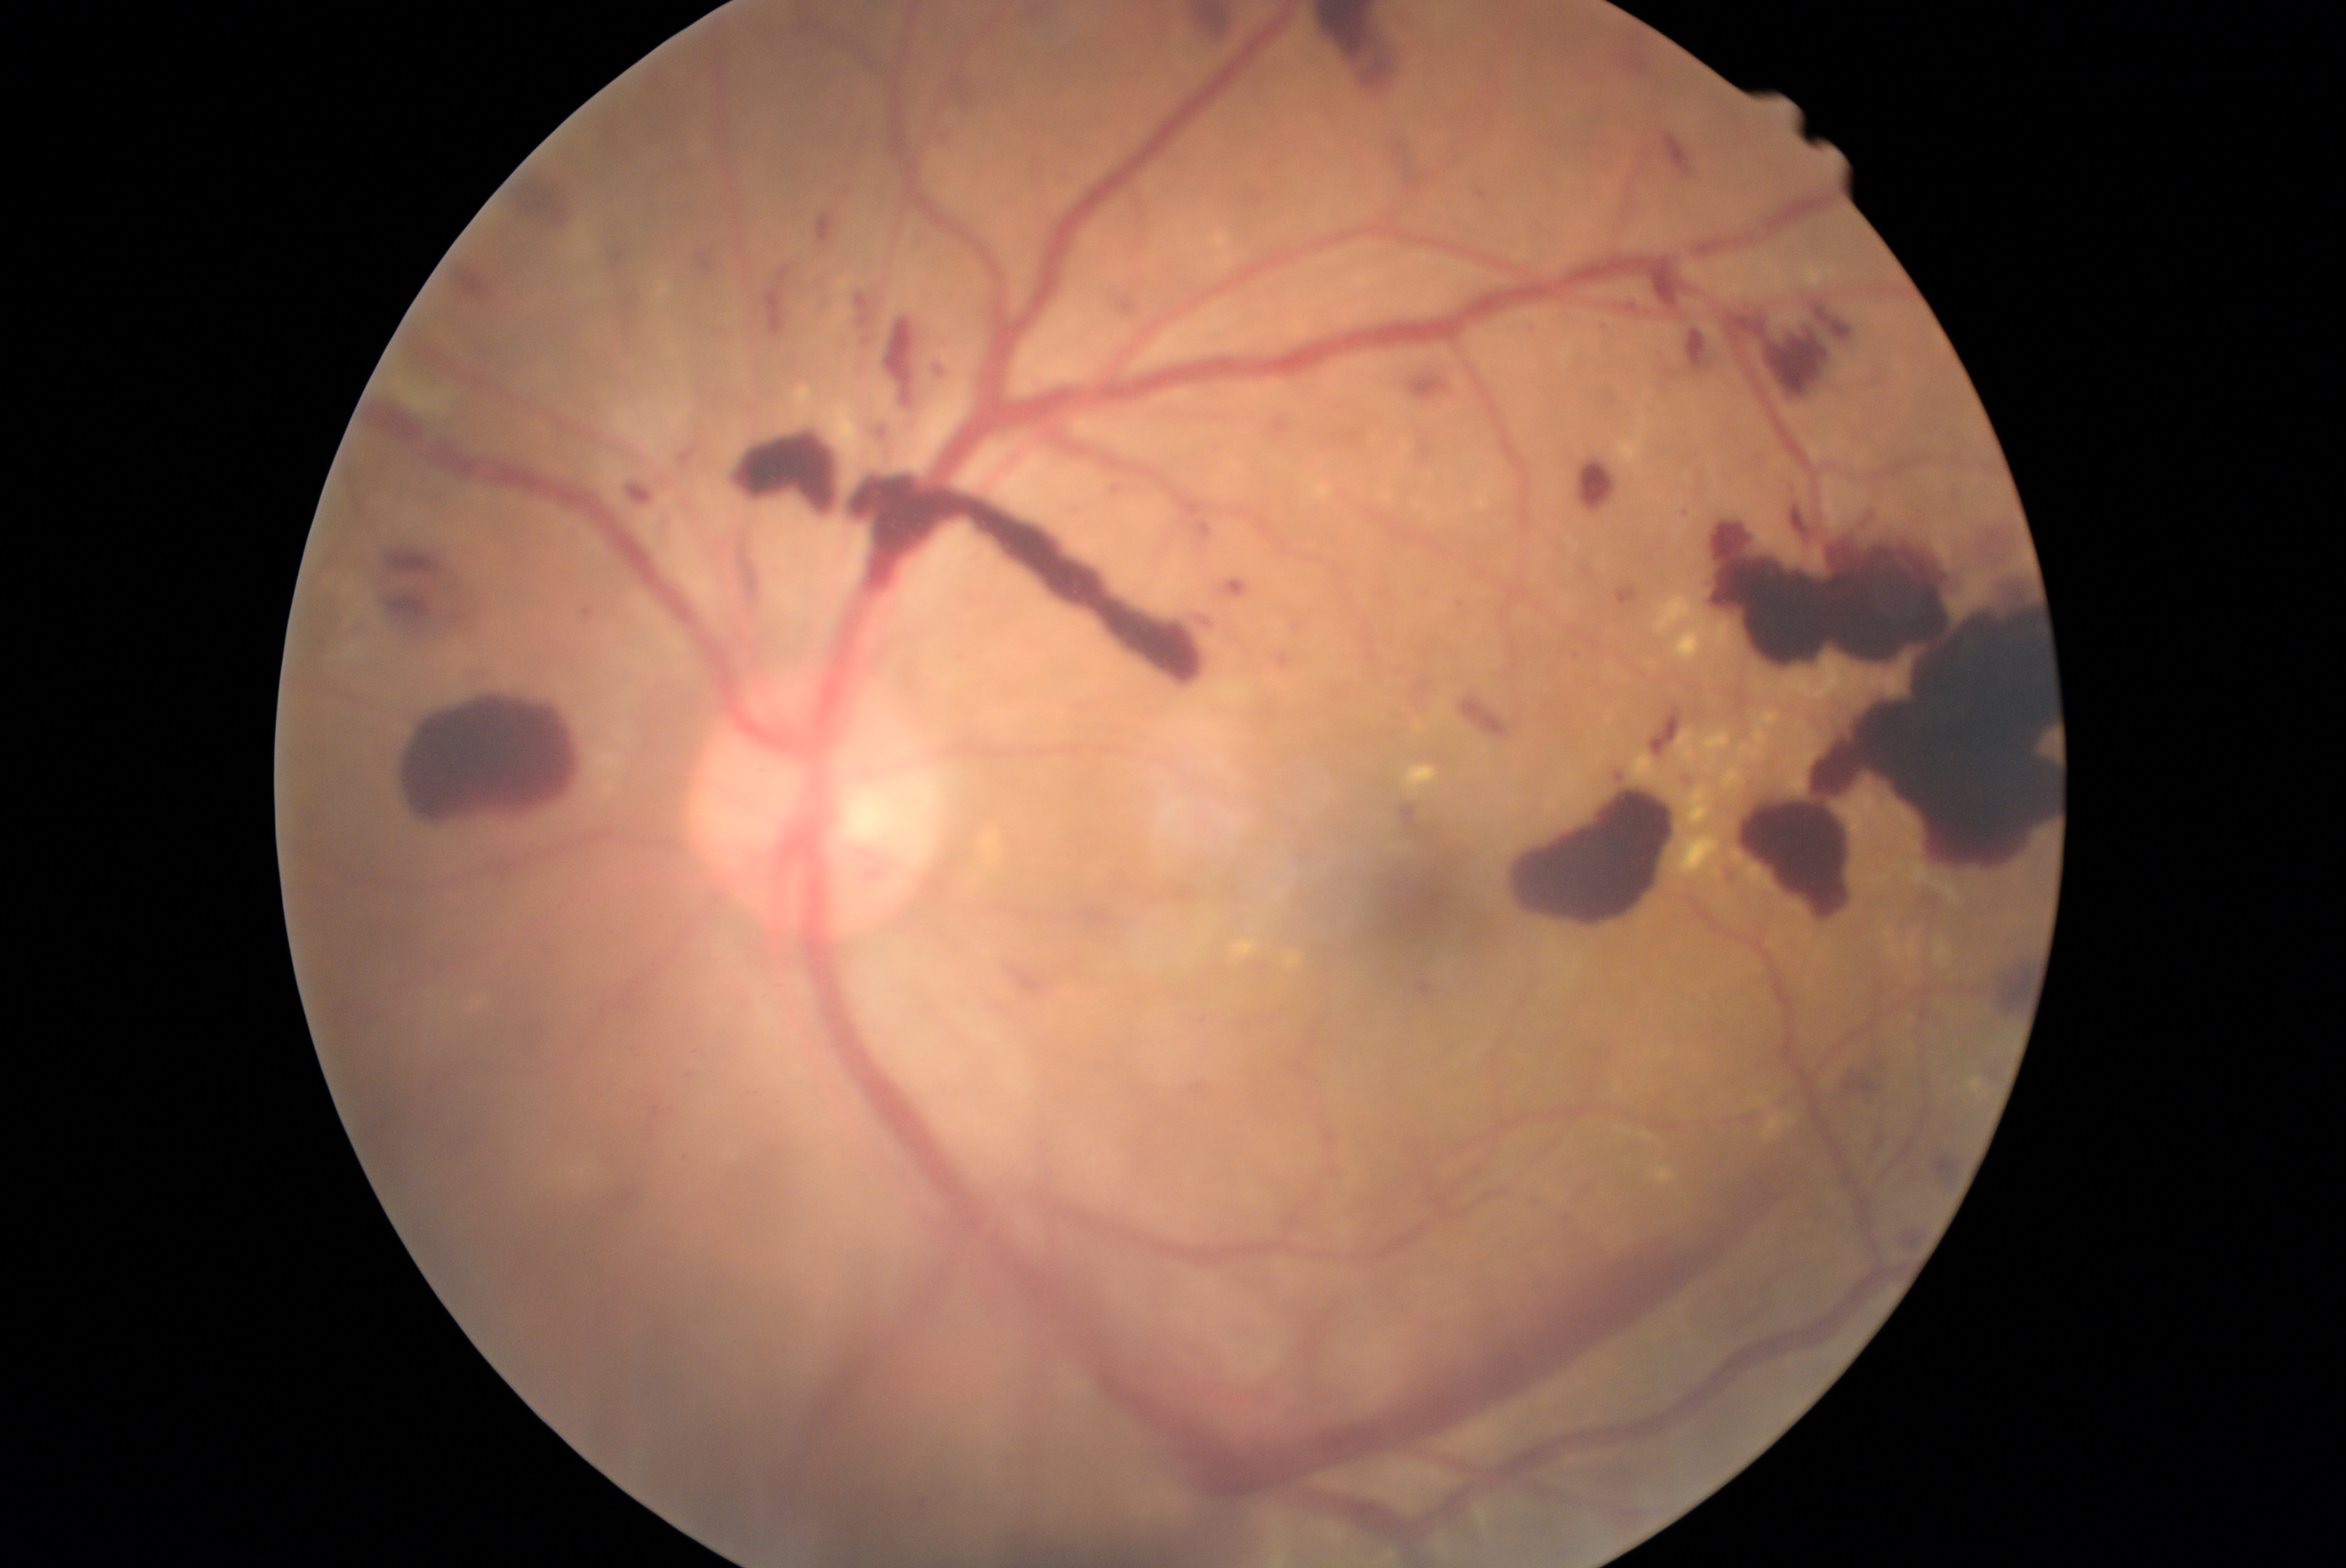
Diabetic retinopathy (DR): grade 4 (PDR).
Hemorrhages (HEs) (partial list) at x1=848, y1=866, x2=888, y2=891 | x1=953, y1=71, x2=992, y2=118 | x1=1064, y1=509, x2=1089, y2=521 | x1=1243, y1=189, x2=1273, y2=212 | x1=1472, y1=181, x2=1494, y2=203 | x1=743, y1=435, x2=1210, y2=684 | x1=948, y1=288, x2=973, y2=308 | x1=1321, y1=402, x2=1379, y2=460 | x1=934, y1=338, x2=951, y2=354 | x1=1003, y1=954, x2=1094, y2=998 | x1=1274, y1=652, x2=1309, y2=675 | x1=647, y1=1091, x2=680, y2=1139 | x1=1459, y1=694, x2=1506, y2=739 | x1=1723, y1=299, x2=1858, y2=407 | x1=1889, y1=1225, x2=1928, y2=1255 | x1=1674, y1=509, x2=1690, y2=521 | x1=694, y1=242, x2=725, y2=281 | x1=1607, y1=761, x2=1627, y2=783.